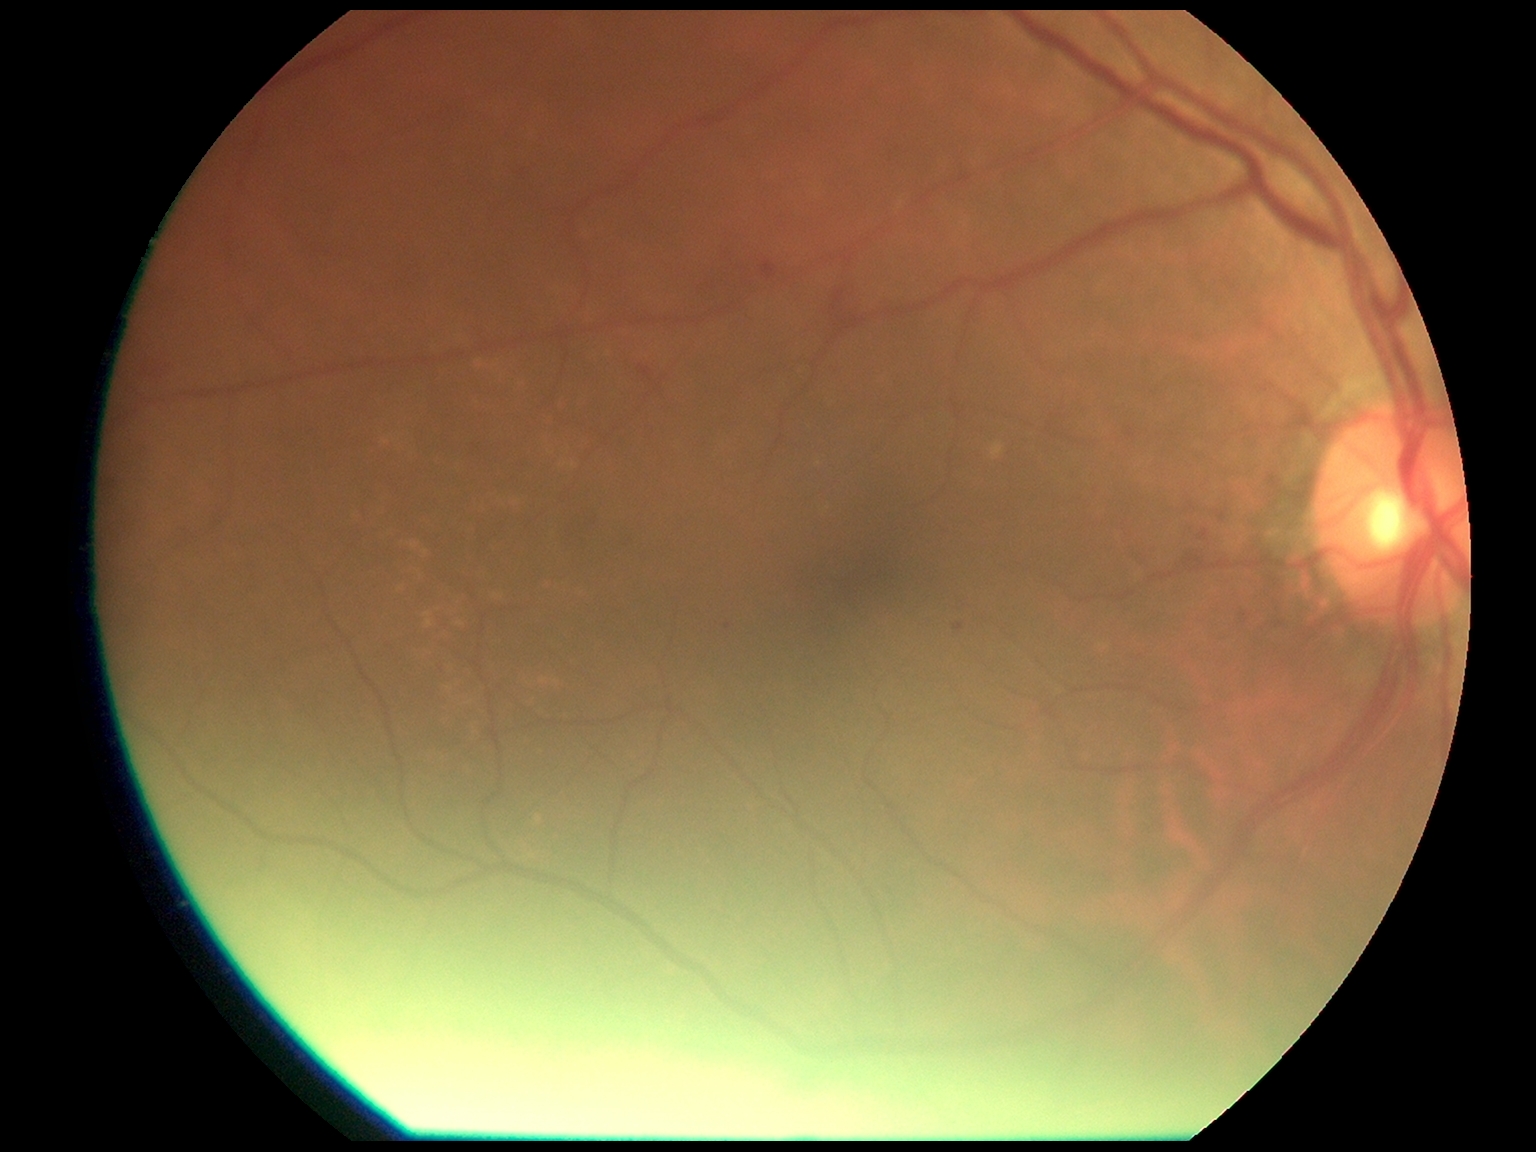

DR = grade 2 (moderate NPDR) | DR class = non-proliferative diabetic retinopathy.